Diabetic retinopathy graded by the modified Davis classification
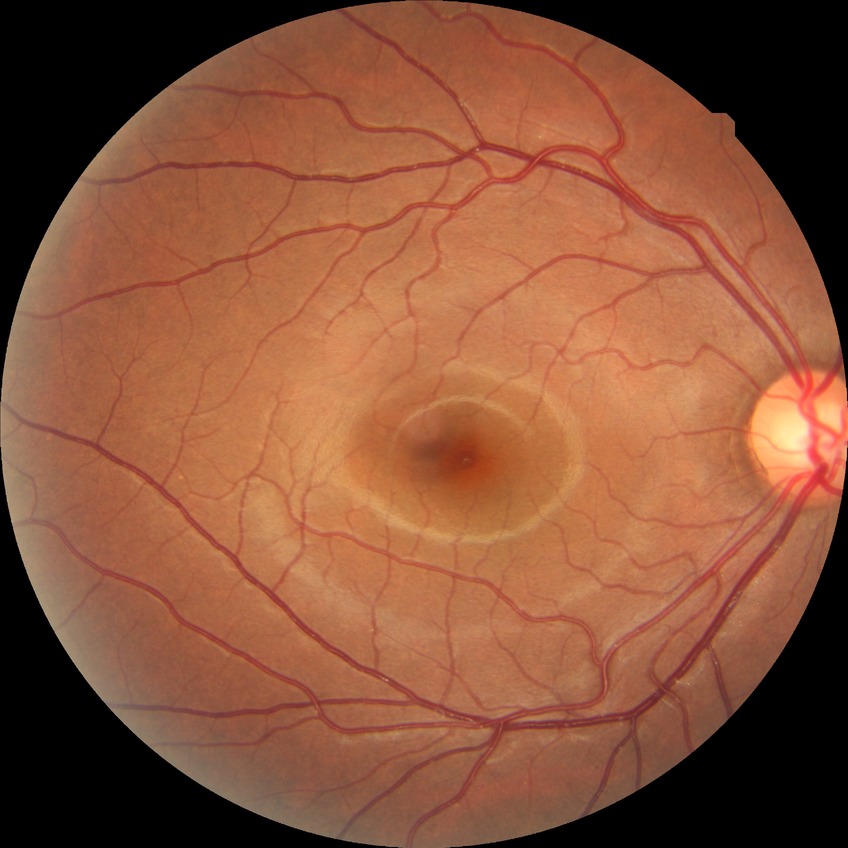
Modified Davis grading: no diabetic retinopathy.